Wide-field fundus image from infant ROP screening; acquired on the Phoenix ICON; image size 1240x1240: 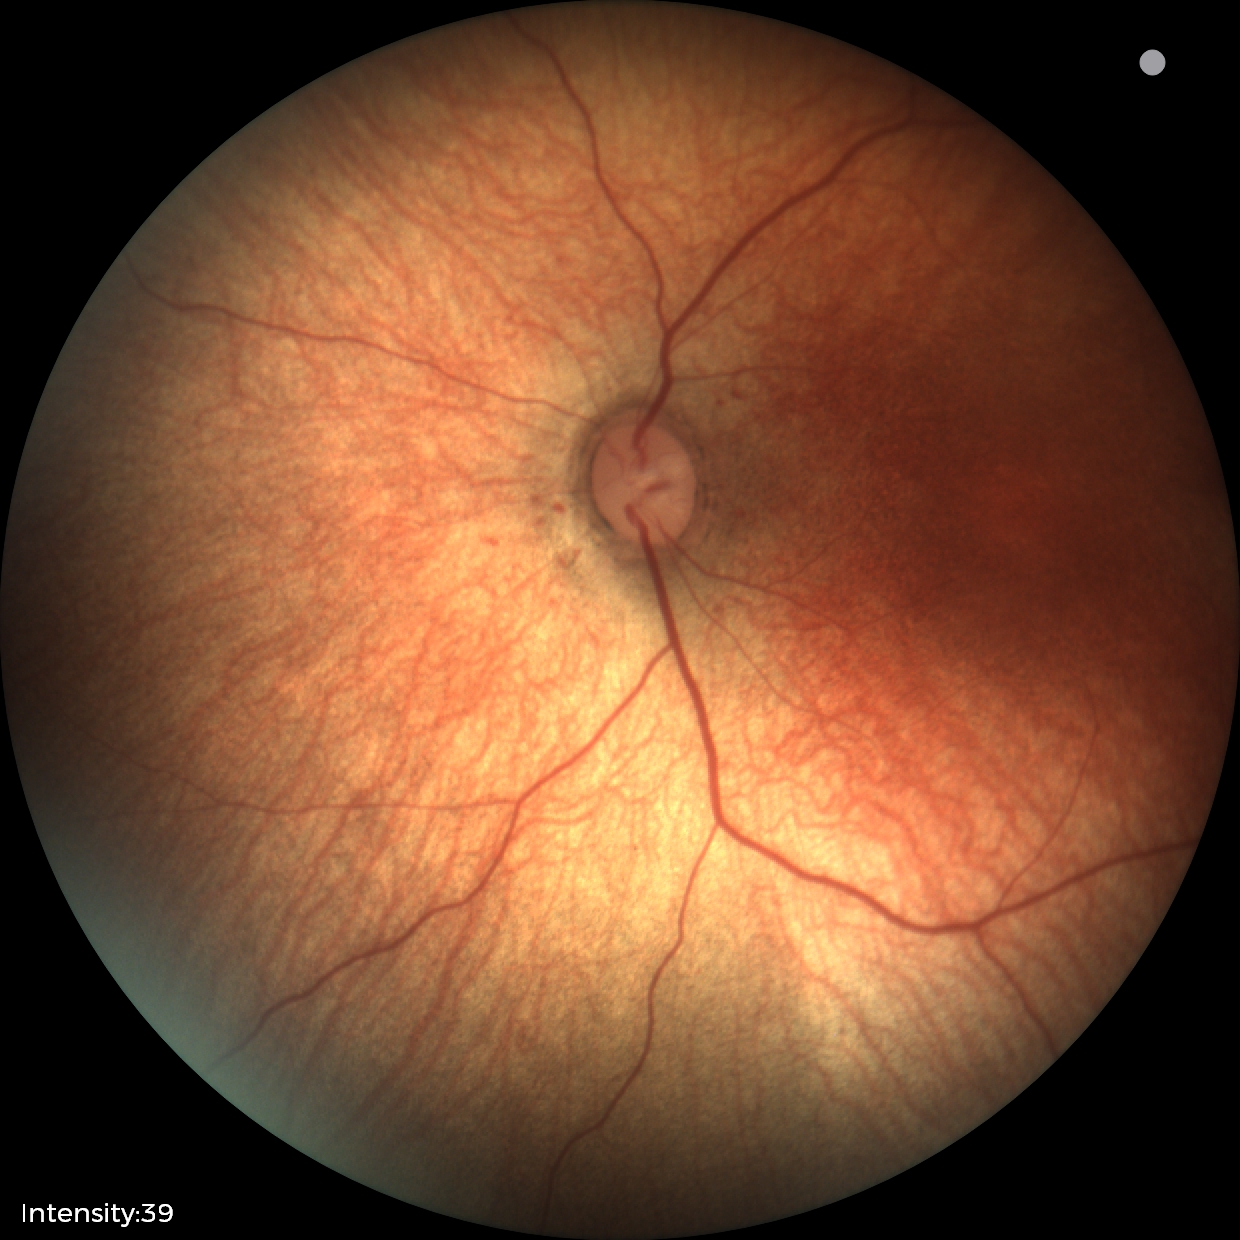
Examination with physiological retinal findings.